45° FOV, CFP, 2352x1568
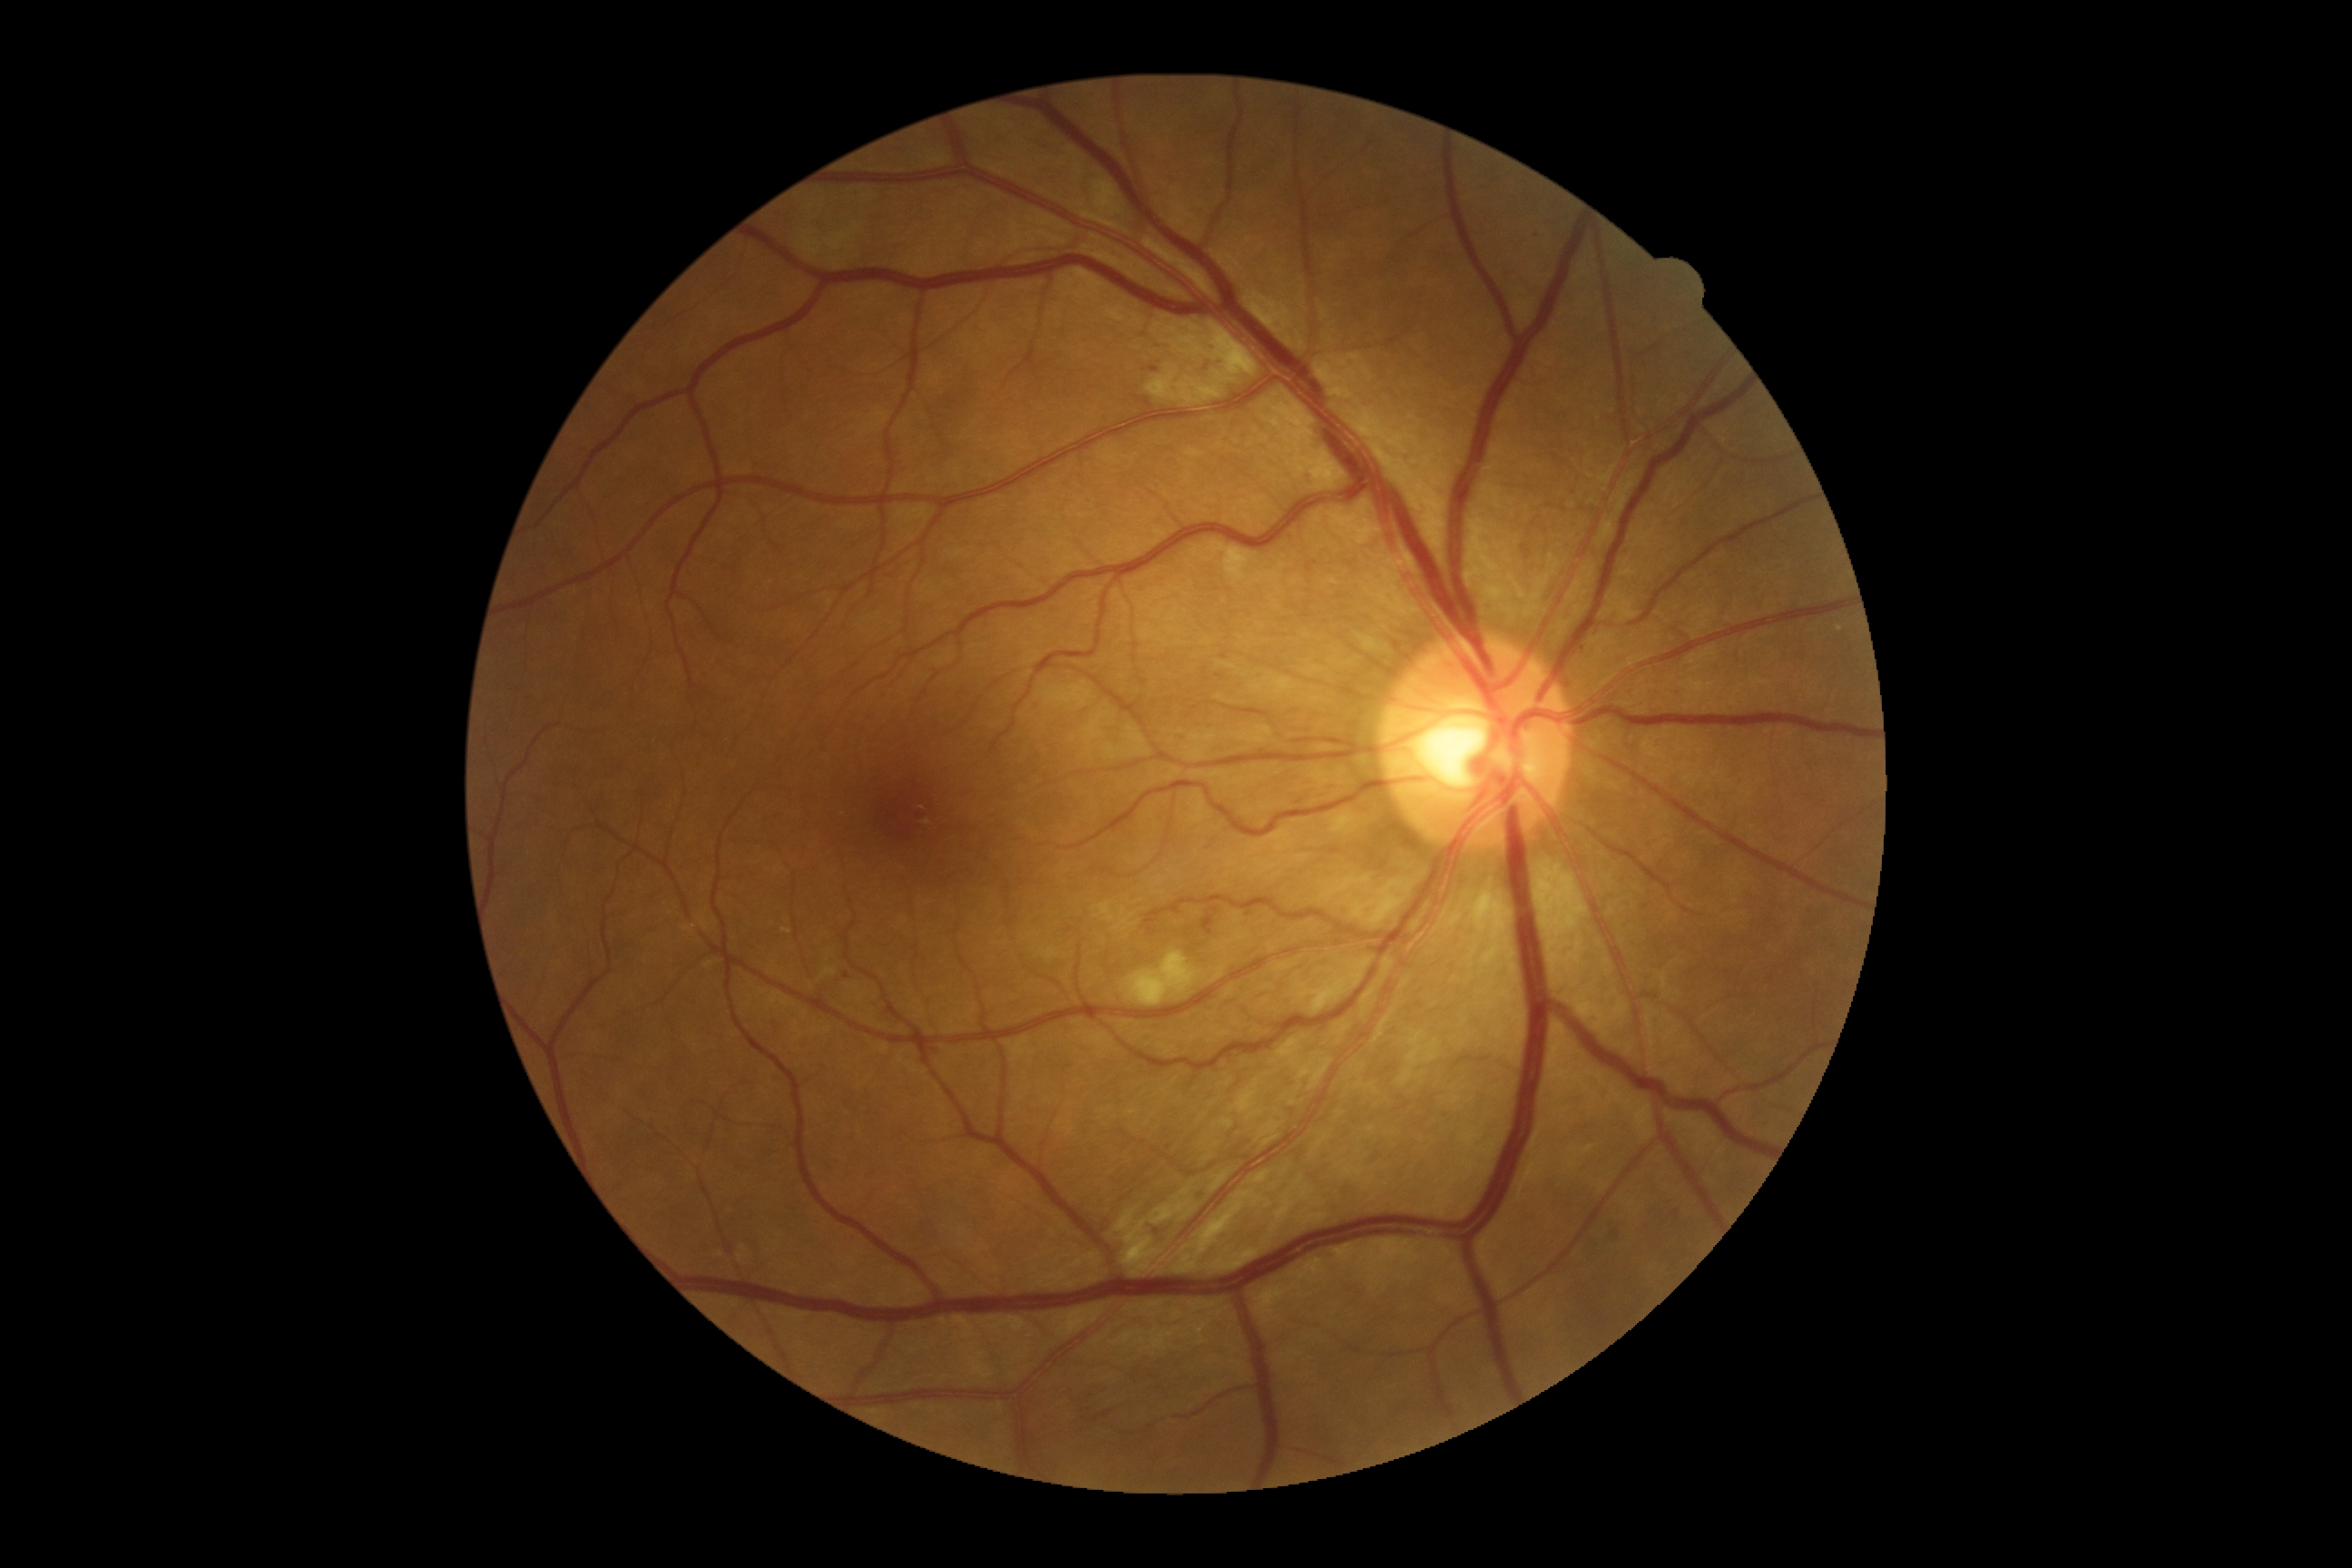

DR stage = grade 2